45° field of view, color fundus image, 2352 x 1568 pixels — 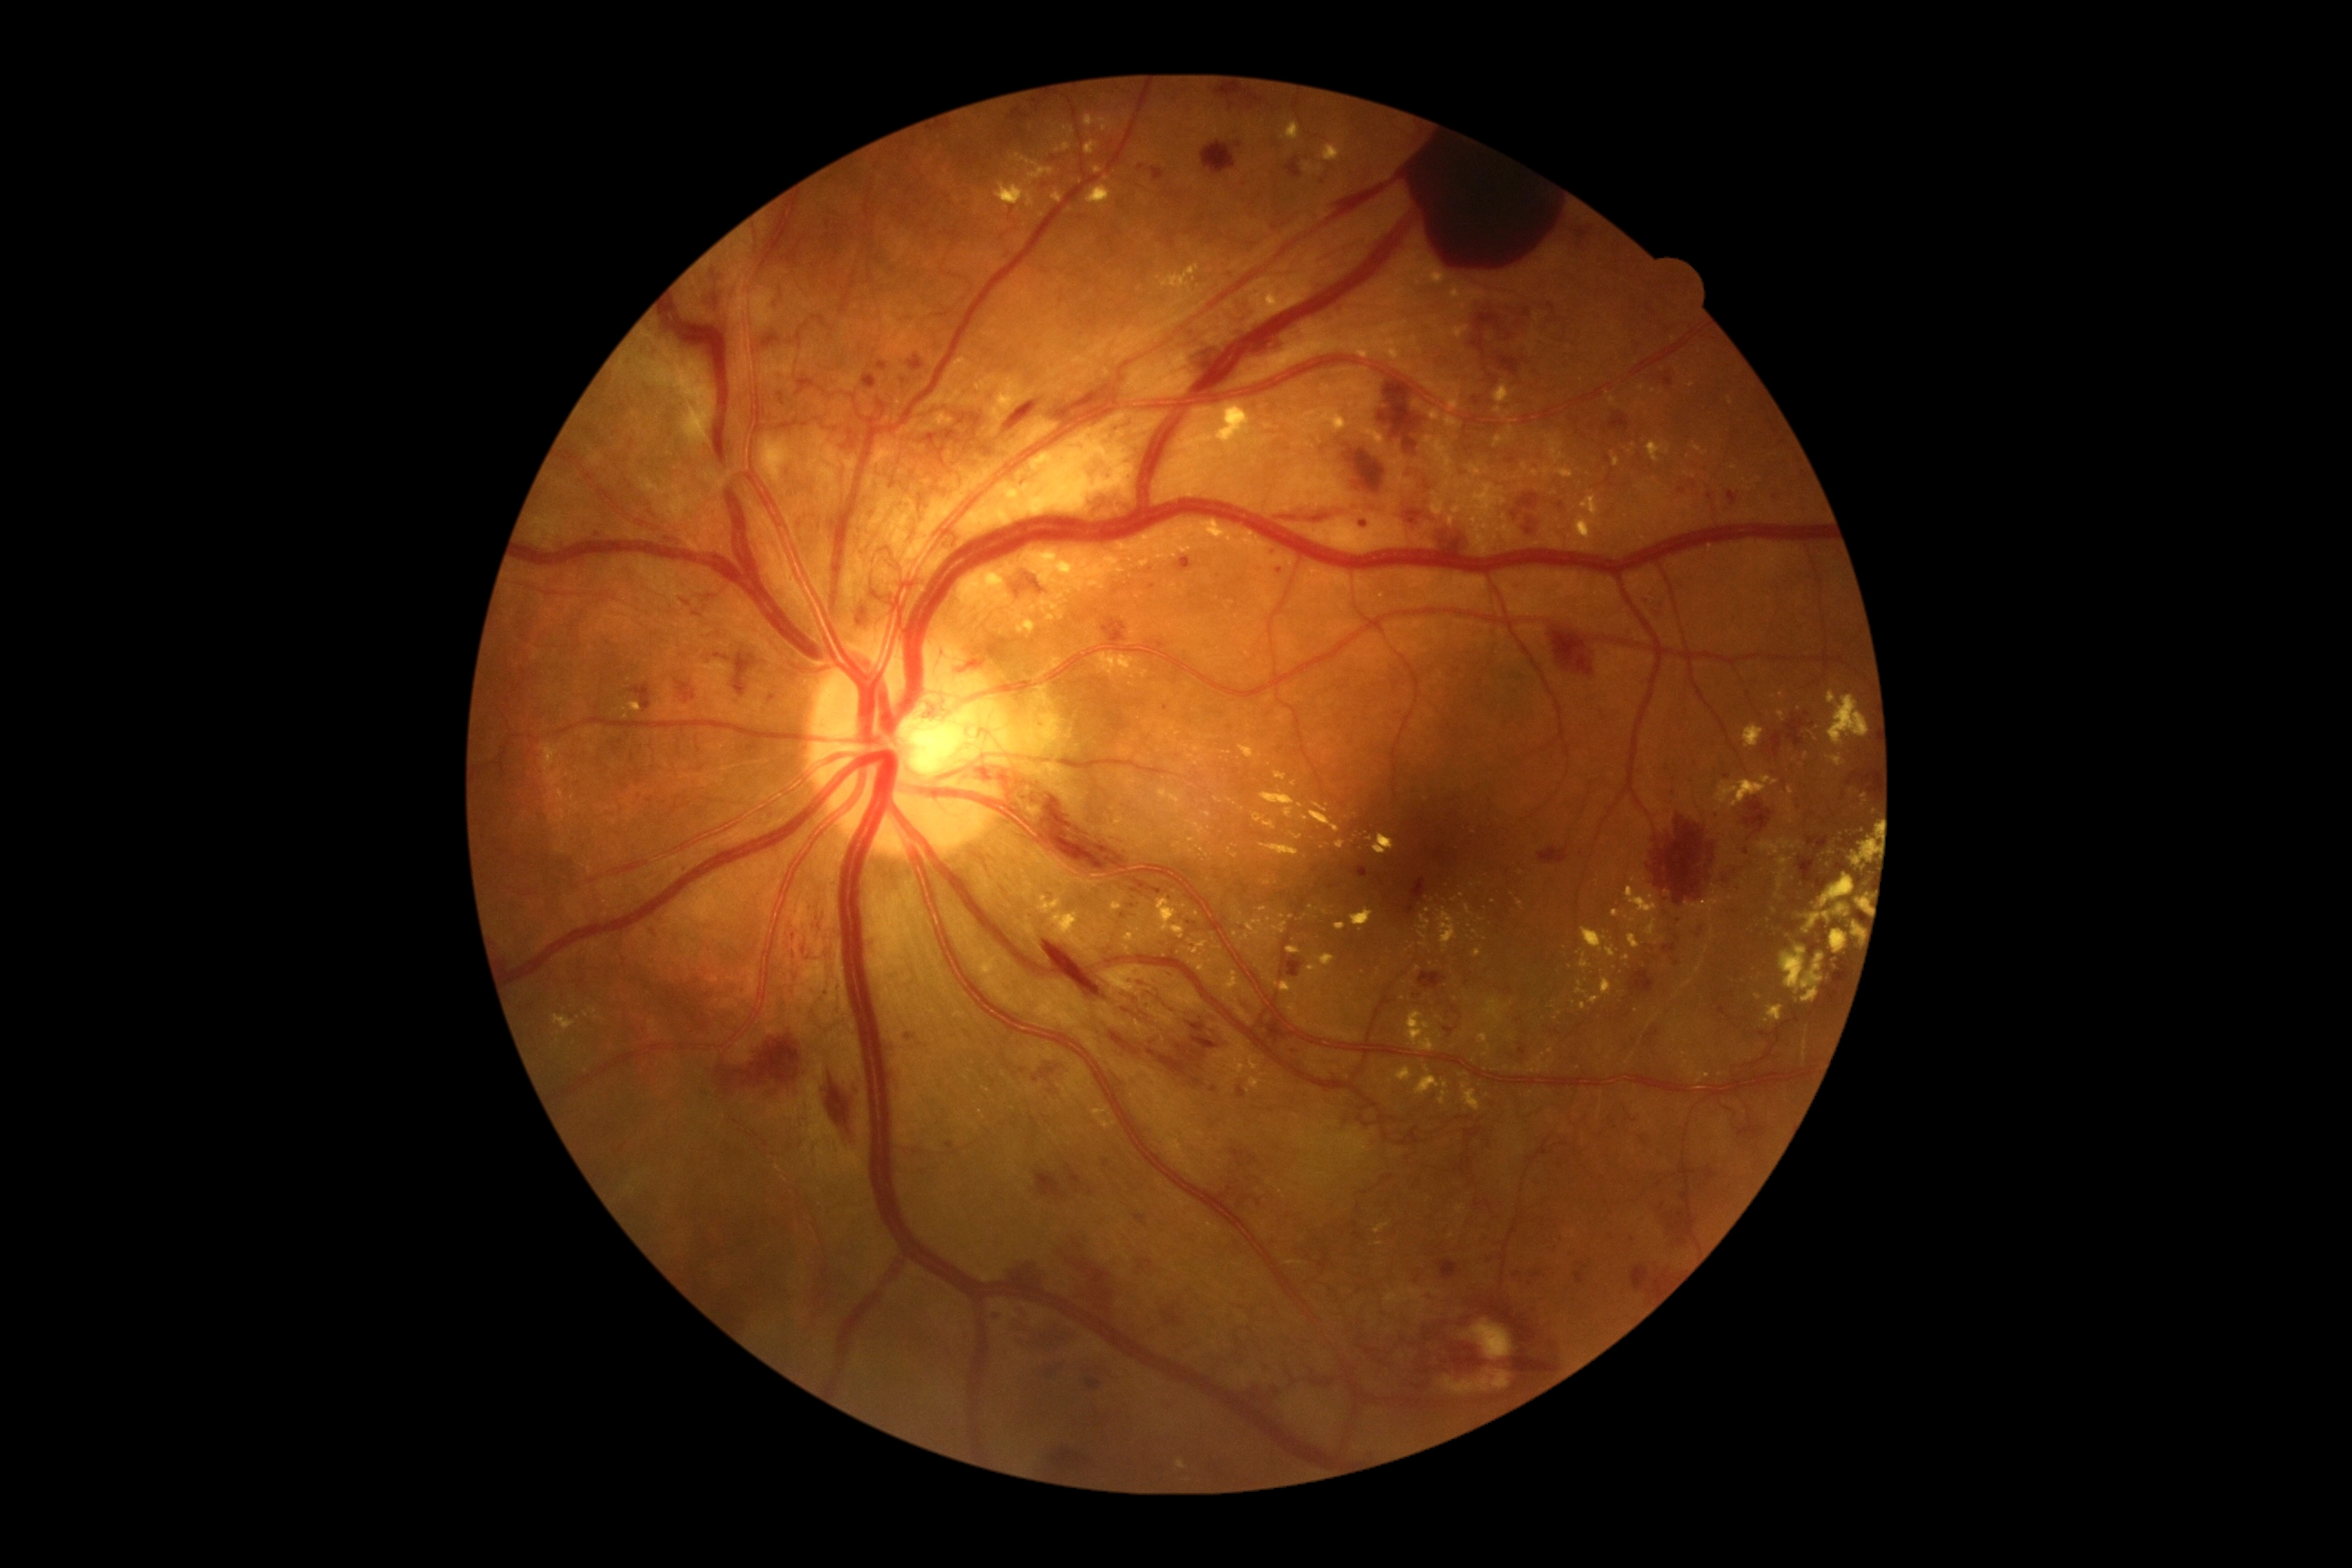 Diabetic retinopathy (DR): 4/4; proliferative diabetic retinopathy
Lesions identified (partial list):
hemorrhages (HEs) (subset): box=[1237, 923, 1250, 936]; box=[776, 393, 790, 407]; box=[1863, 825, 1872, 832]; box=[1148, 583, 1157, 591]; box=[1055, 1235, 1119, 1318]; box=[1856, 874, 1867, 887]; box=[1553, 632, 1594, 676]; box=[683, 602, 691, 607]; box=[767, 288, 785, 315]; box=[1511, 495, 1542, 518]; box=[1745, 798, 1774, 834]; box=[1106, 1072, 1124, 1086]; box=[1220, 1186, 1237, 1210]; box=[1799, 858, 1836, 894]; box=[1839, 787, 1845, 803]
Small HEs near {"x": 1090, "y": 1194}; {"x": 1324, "y": 182}; {"x": 1669, "y": 1218}
hard exudates (EXs) (subset): box=[1438, 908, 1458, 954]; box=[1416, 1075, 1440, 1097]; box=[1827, 754, 1845, 769]; box=[1055, 142, 1072, 153]; box=[1418, 932, 1427, 941]; box=[1779, 946, 1827, 1003]; box=[1250, 1079, 1262, 1090]; box=[1148, 899, 1186, 941]; box=[1518, 901, 1524, 910]; box=[1494, 384, 1516, 404]; box=[1856, 897, 1865, 910]
Small EXs near {"x": 1229, "y": 754}; {"x": 1805, "y": 757}; {"x": 1149, "y": 724}; {"x": 1210, "y": 738}; {"x": 1120, "y": 570}; {"x": 1462, "y": 895}; {"x": 1325, "y": 913}